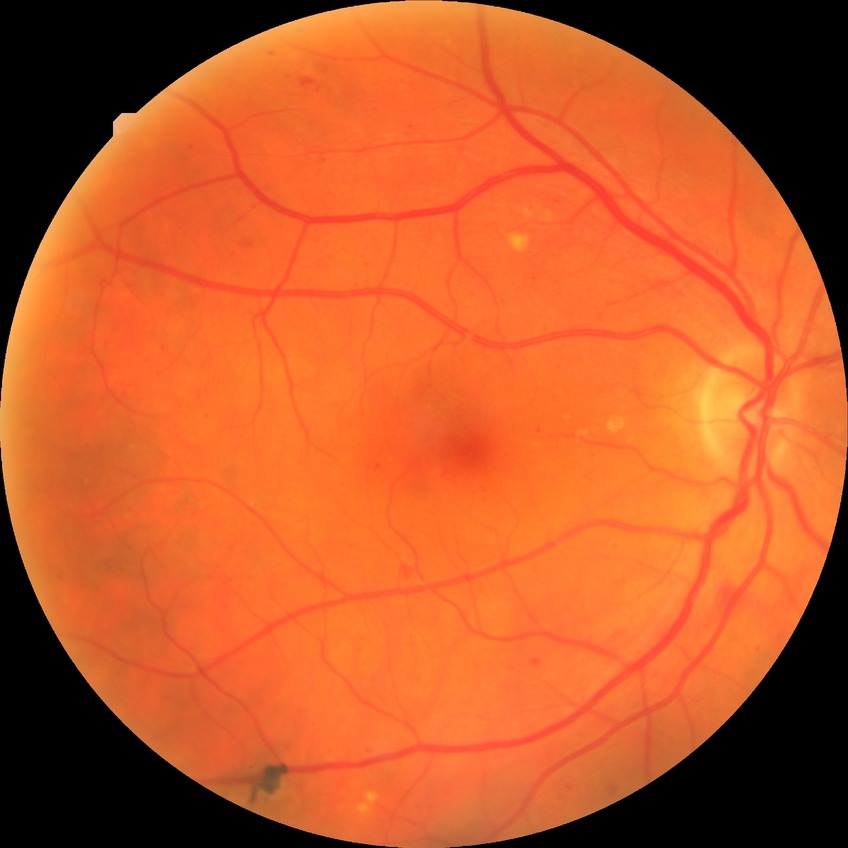

Diabetic retinopathy (DR) is simple diabetic retinopathy (SDR).